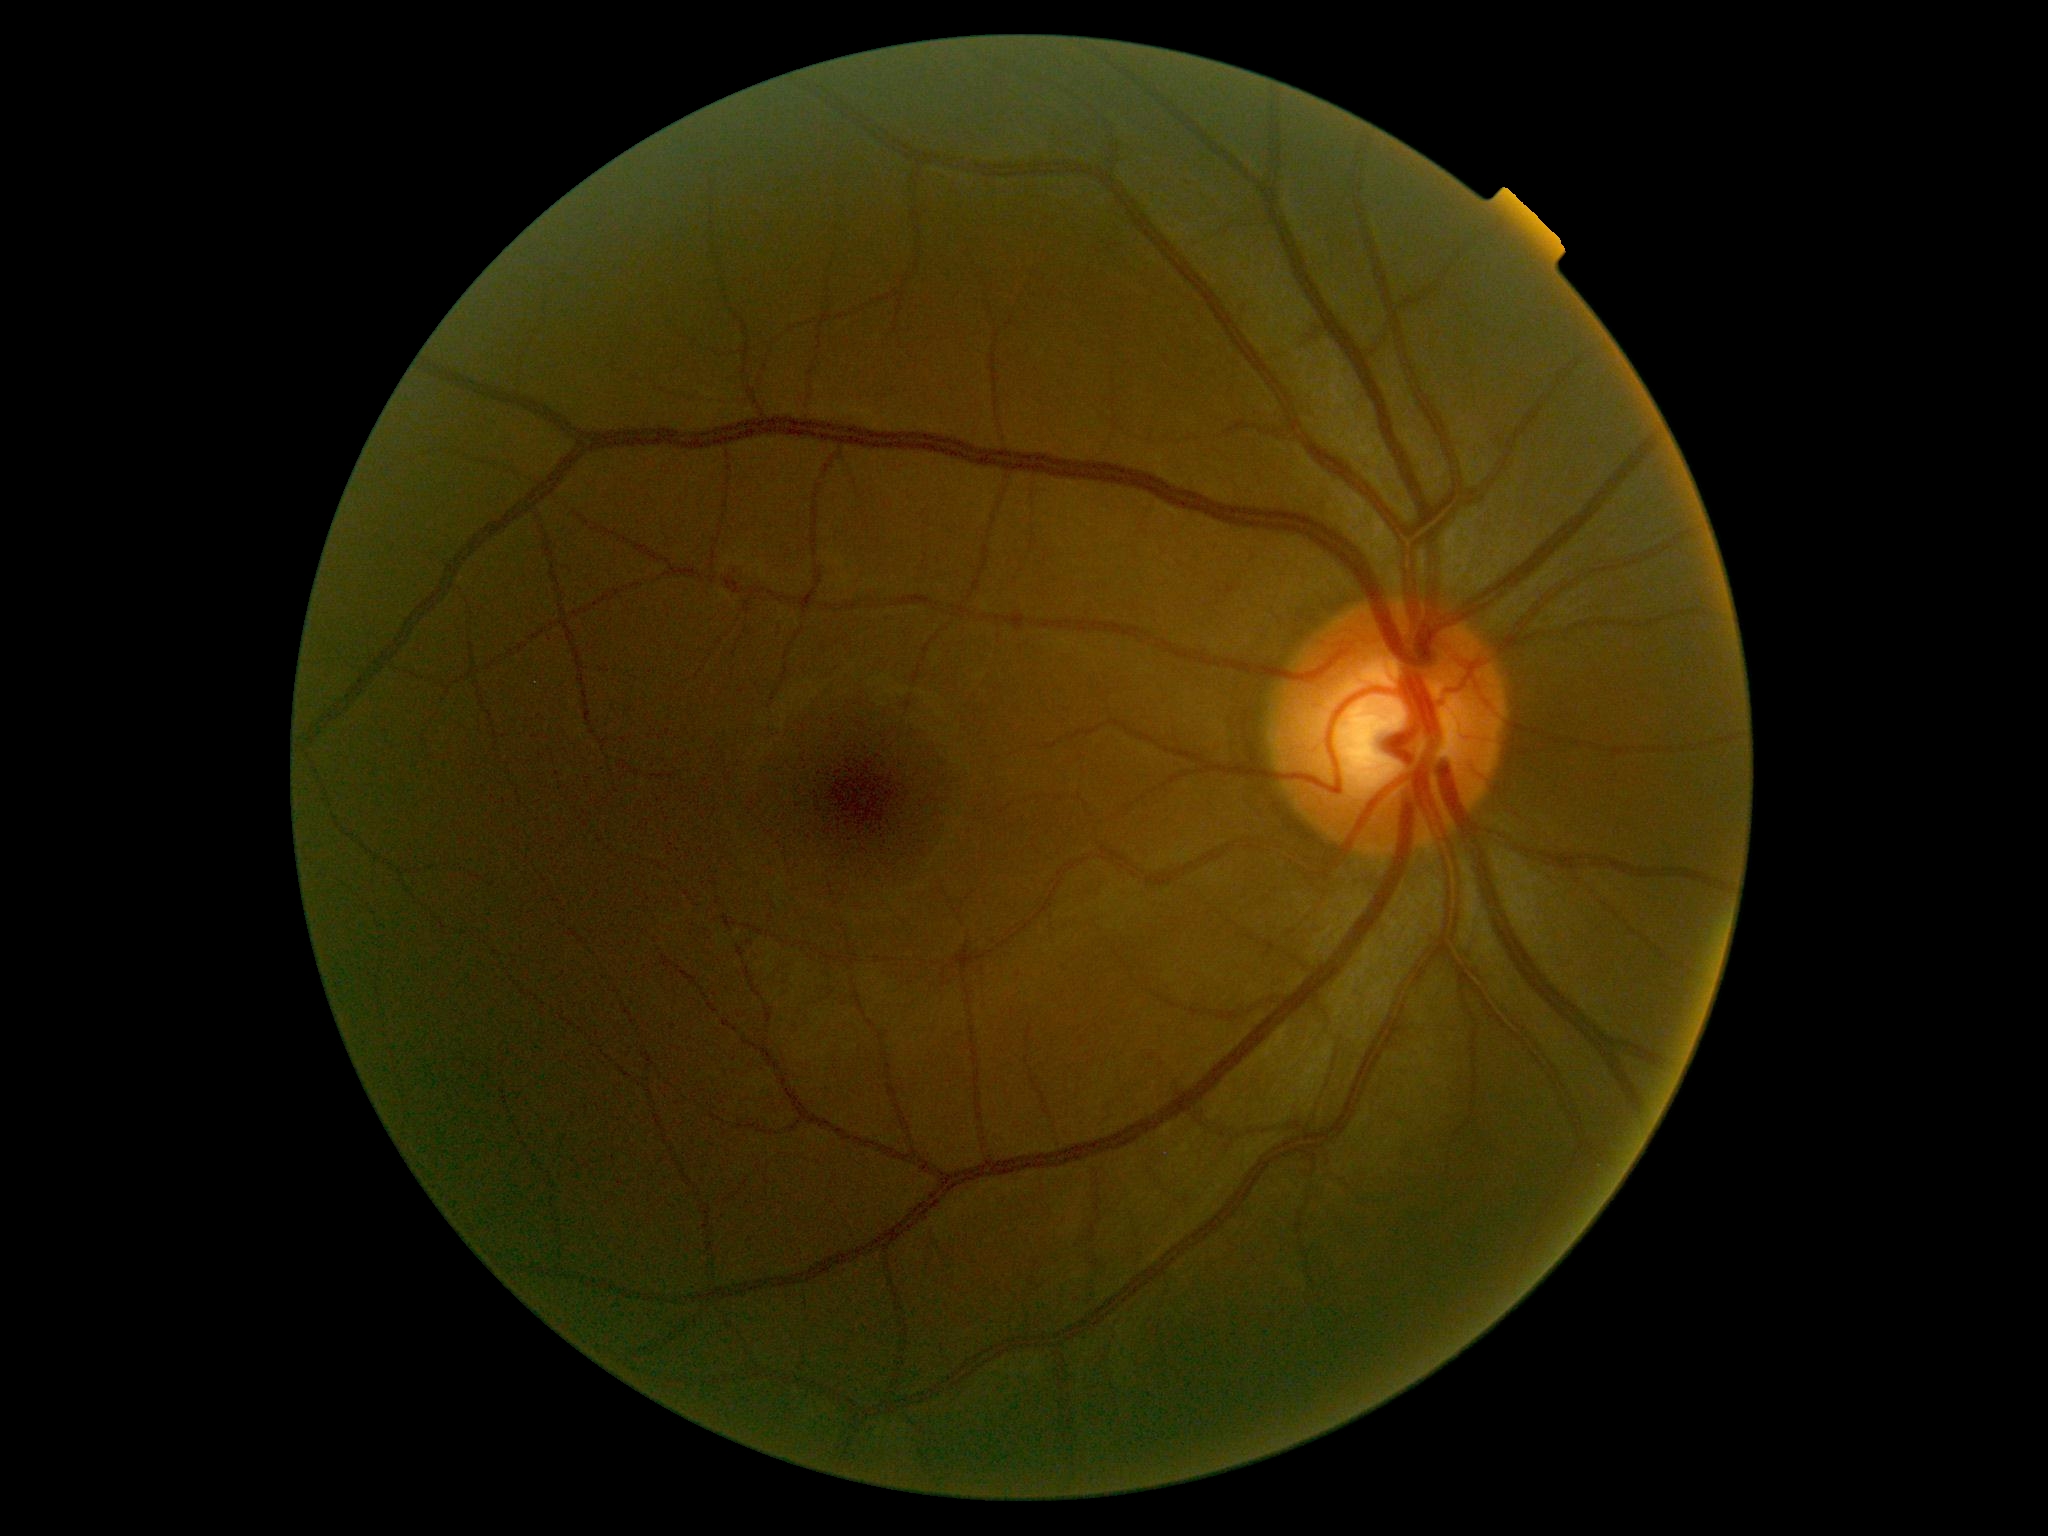

Diabetic retinopathy severity: grade 0 (no apparent retinopathy) — no visible signs of diabetic retinopathy.